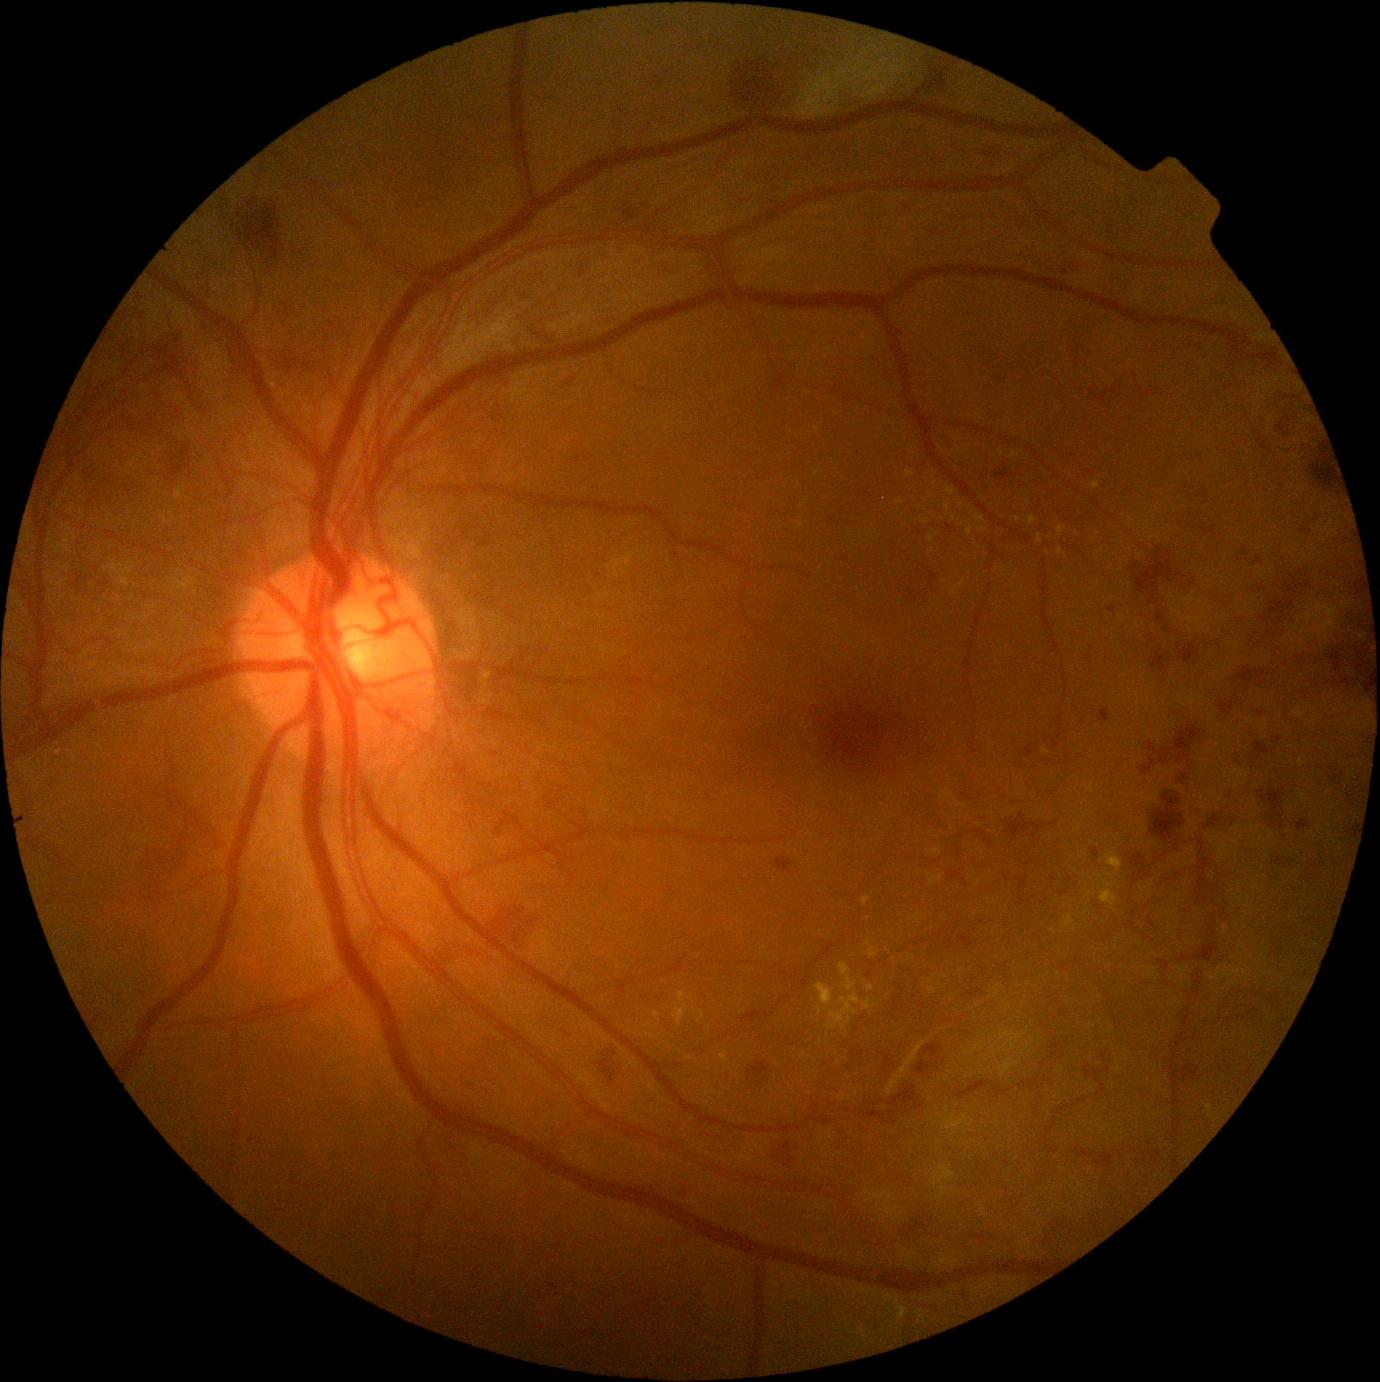 DR class: proliferative diabetic retinopathy. Diabetic retinopathy (DR) is proliferative diabetic retinopathy (grade 4).